848x848px, 45 degree fundus photograph, DR severity per modified Davis staging: 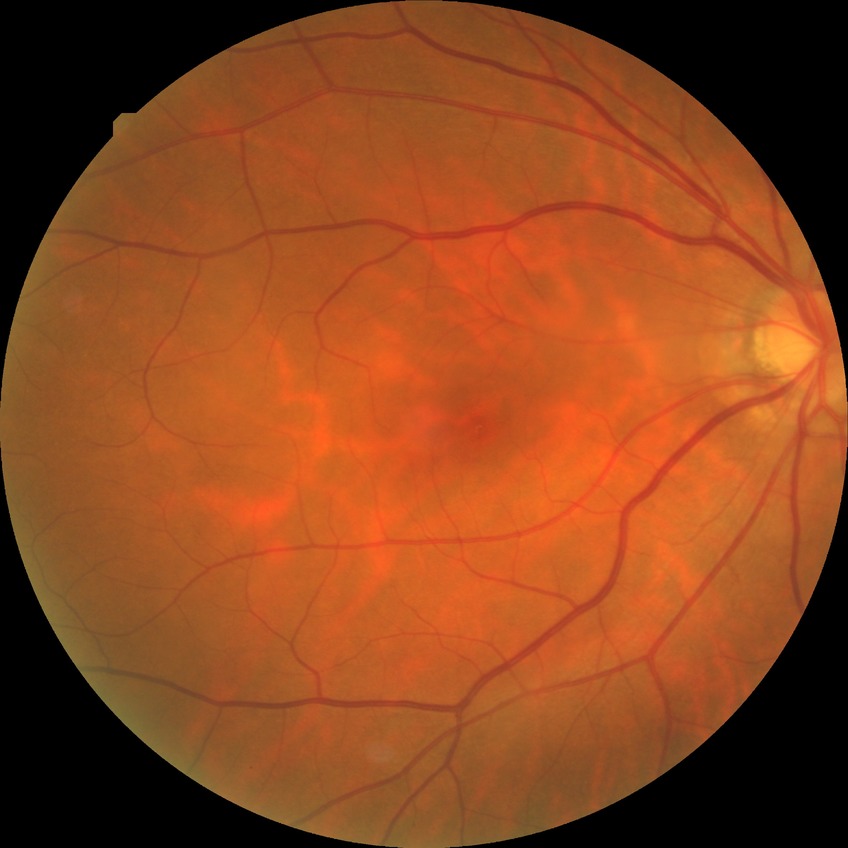
Retinopathy stage: no diabetic retinopathy.